No pharmacologic dilation. NIDEK AFC-230.
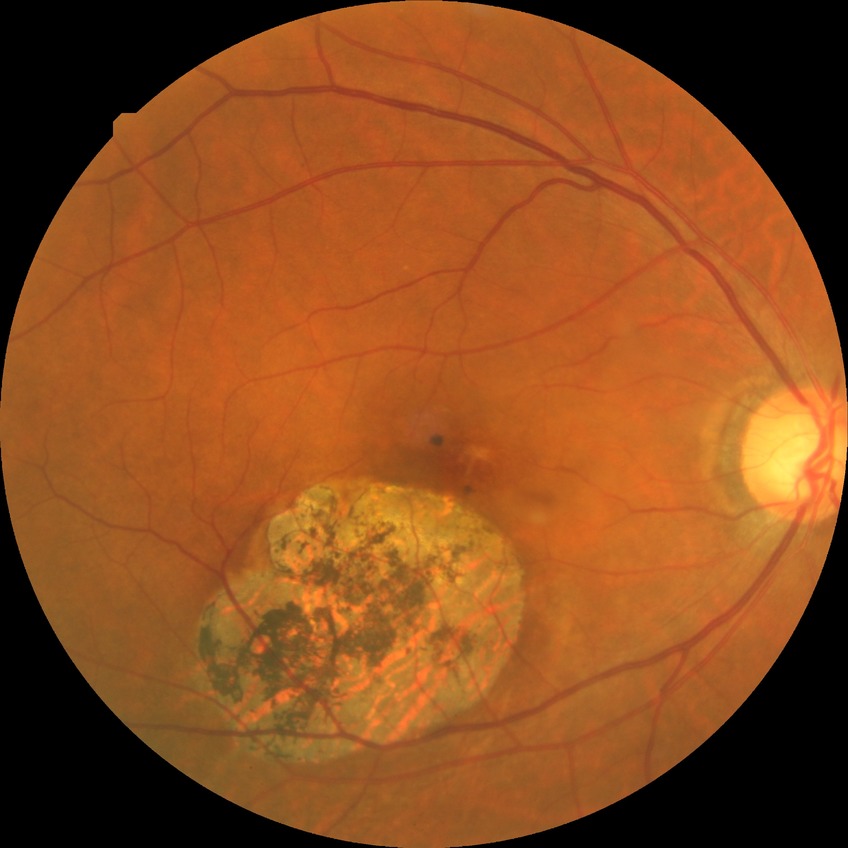 Diabetic retinopathy severity is no diabetic retinopathy.